512x512px.
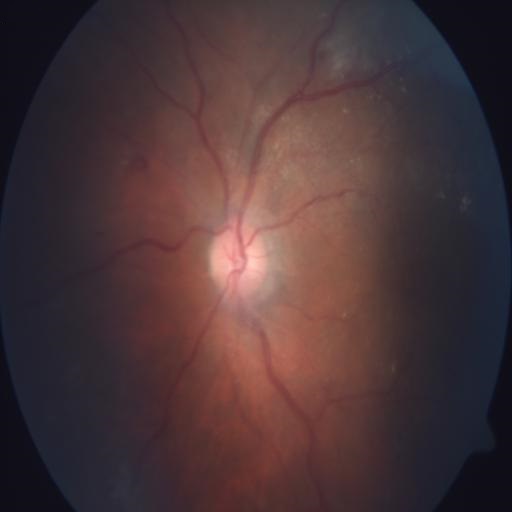
Two findings. Demonstrates tortuous vessels & optic disc pallor.